1659 by 2212 pixels; acquired with a Remidio Fundus on Phone: 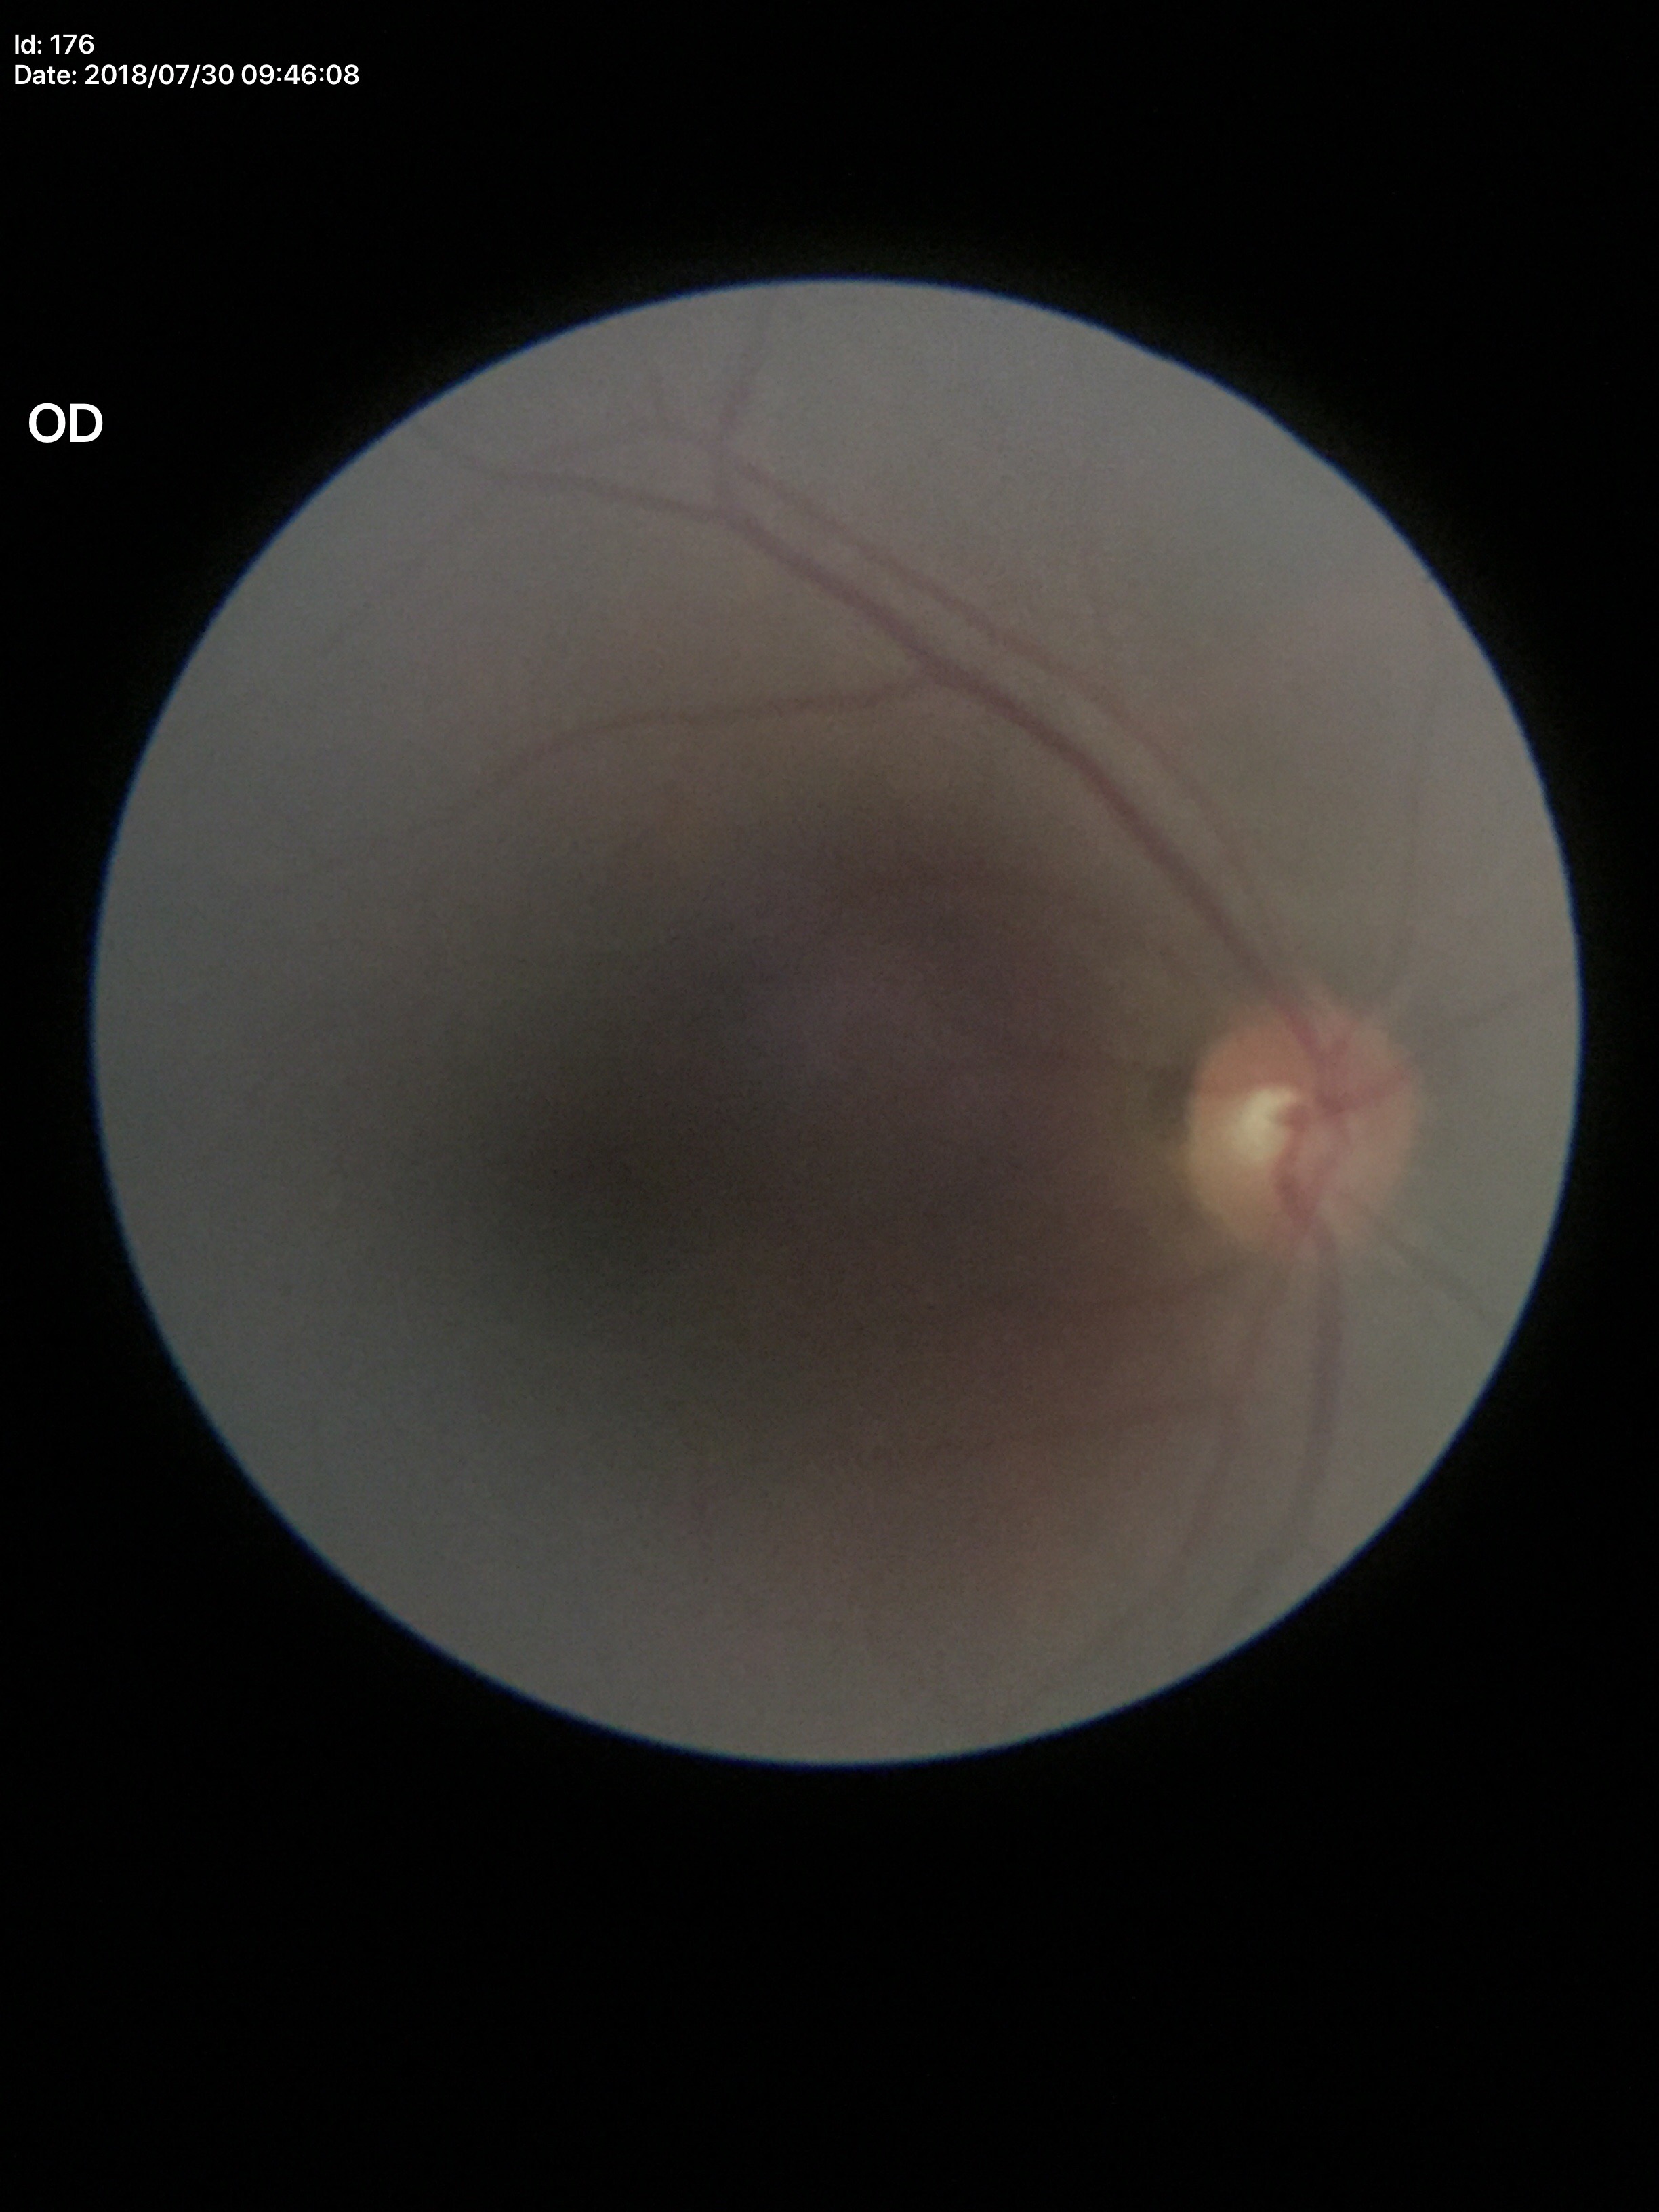
Q: What is the glaucoma assessment?
A: not suspect
Q: What is the VCDR?
A: 0.48